848x848px. NIDEK AFC-230 fundus camera
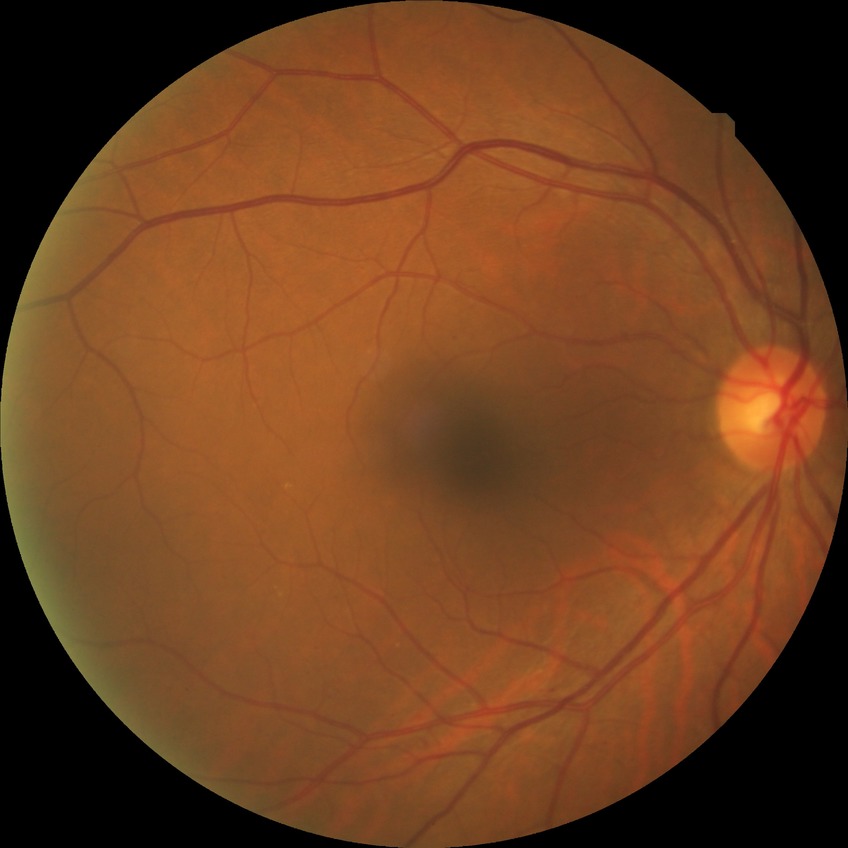

davis_grade: simple diabetic retinopathy (SDR)
proliferative_class: non-proliferative diabetic retinopathy